45° FOV, NIDEK AFC-230 fundus camera.
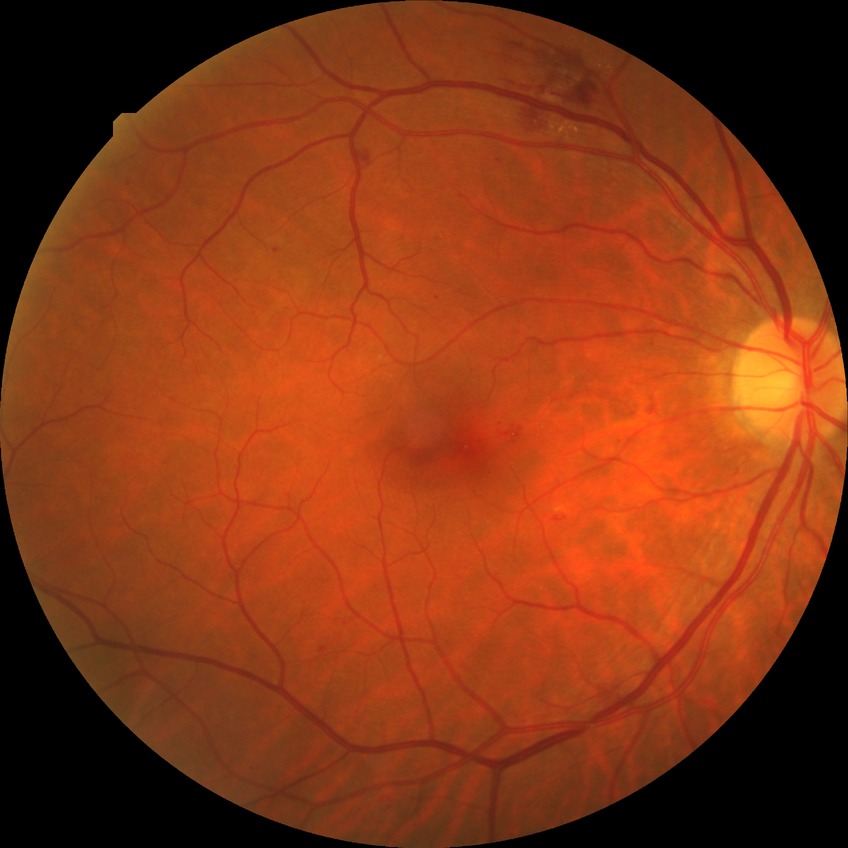 Modified Davis grade: SDR.